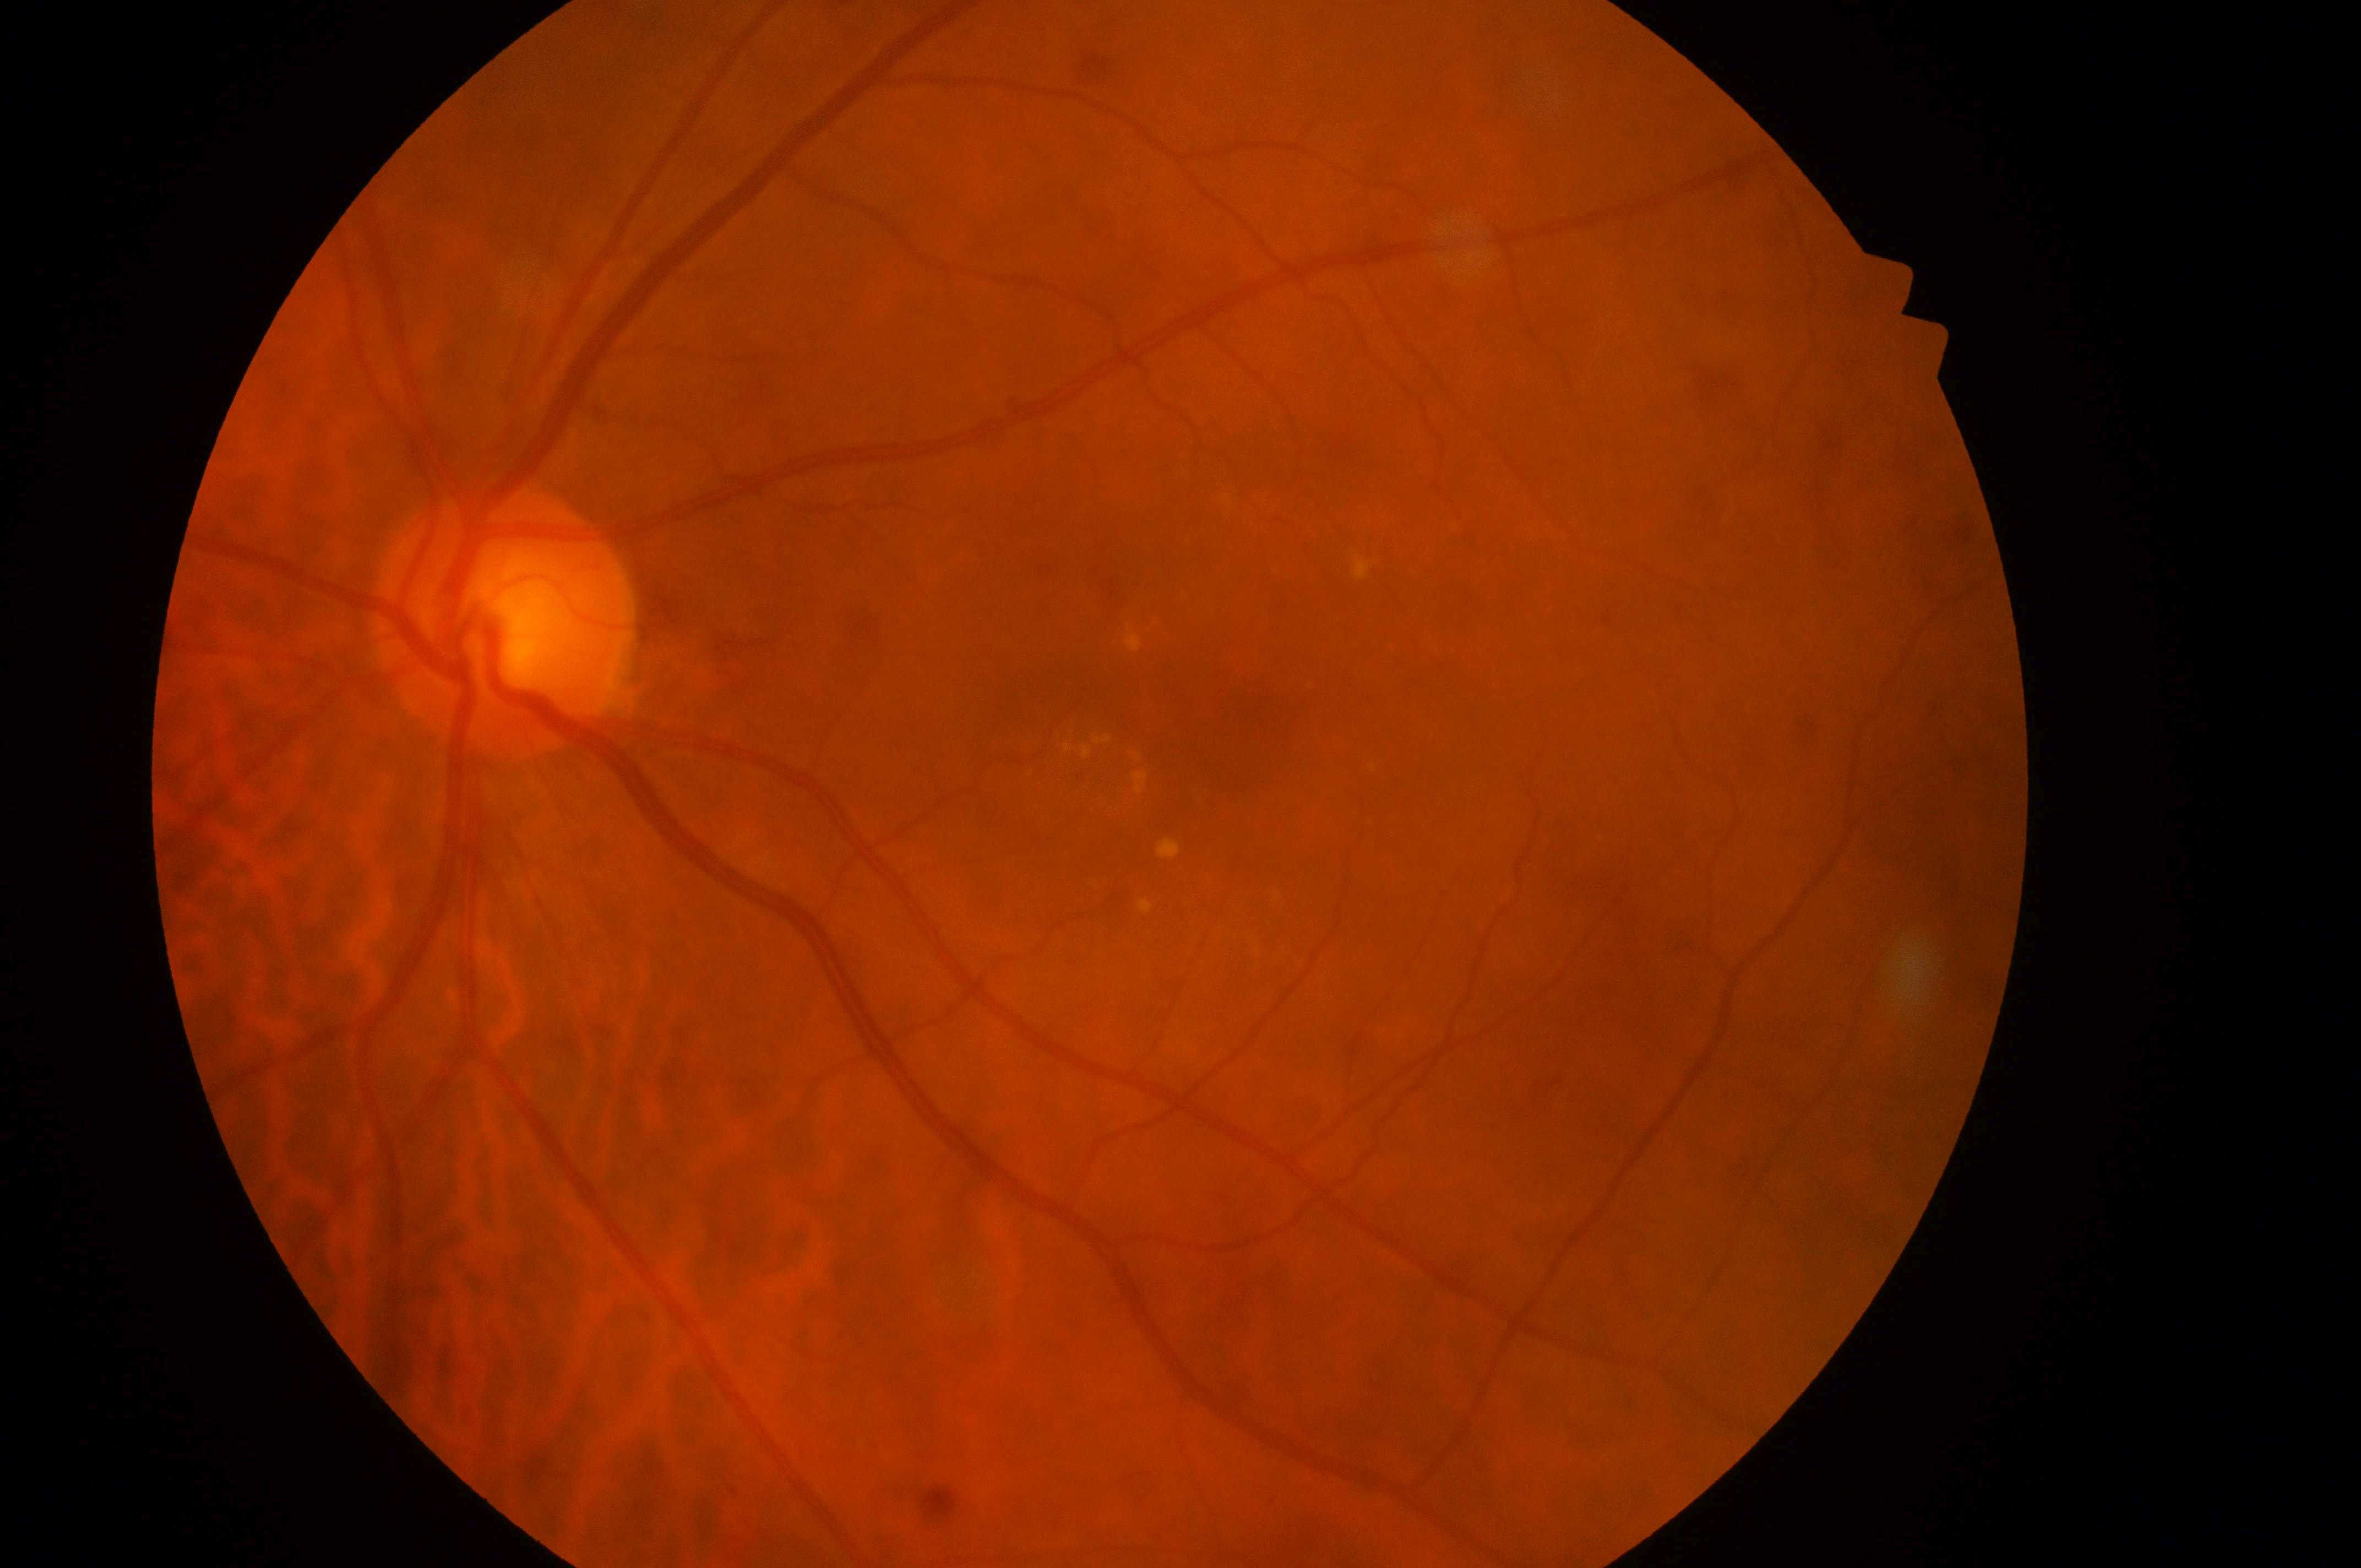

DME: 2/2 — hard exudates within one disc diameter of the macula center. Optic disc: (x=497, y=627). Fovea: (x=1248, y=723). Eye: OS. DR: 2 — more than just microaneurysms but less than severe NPDR.